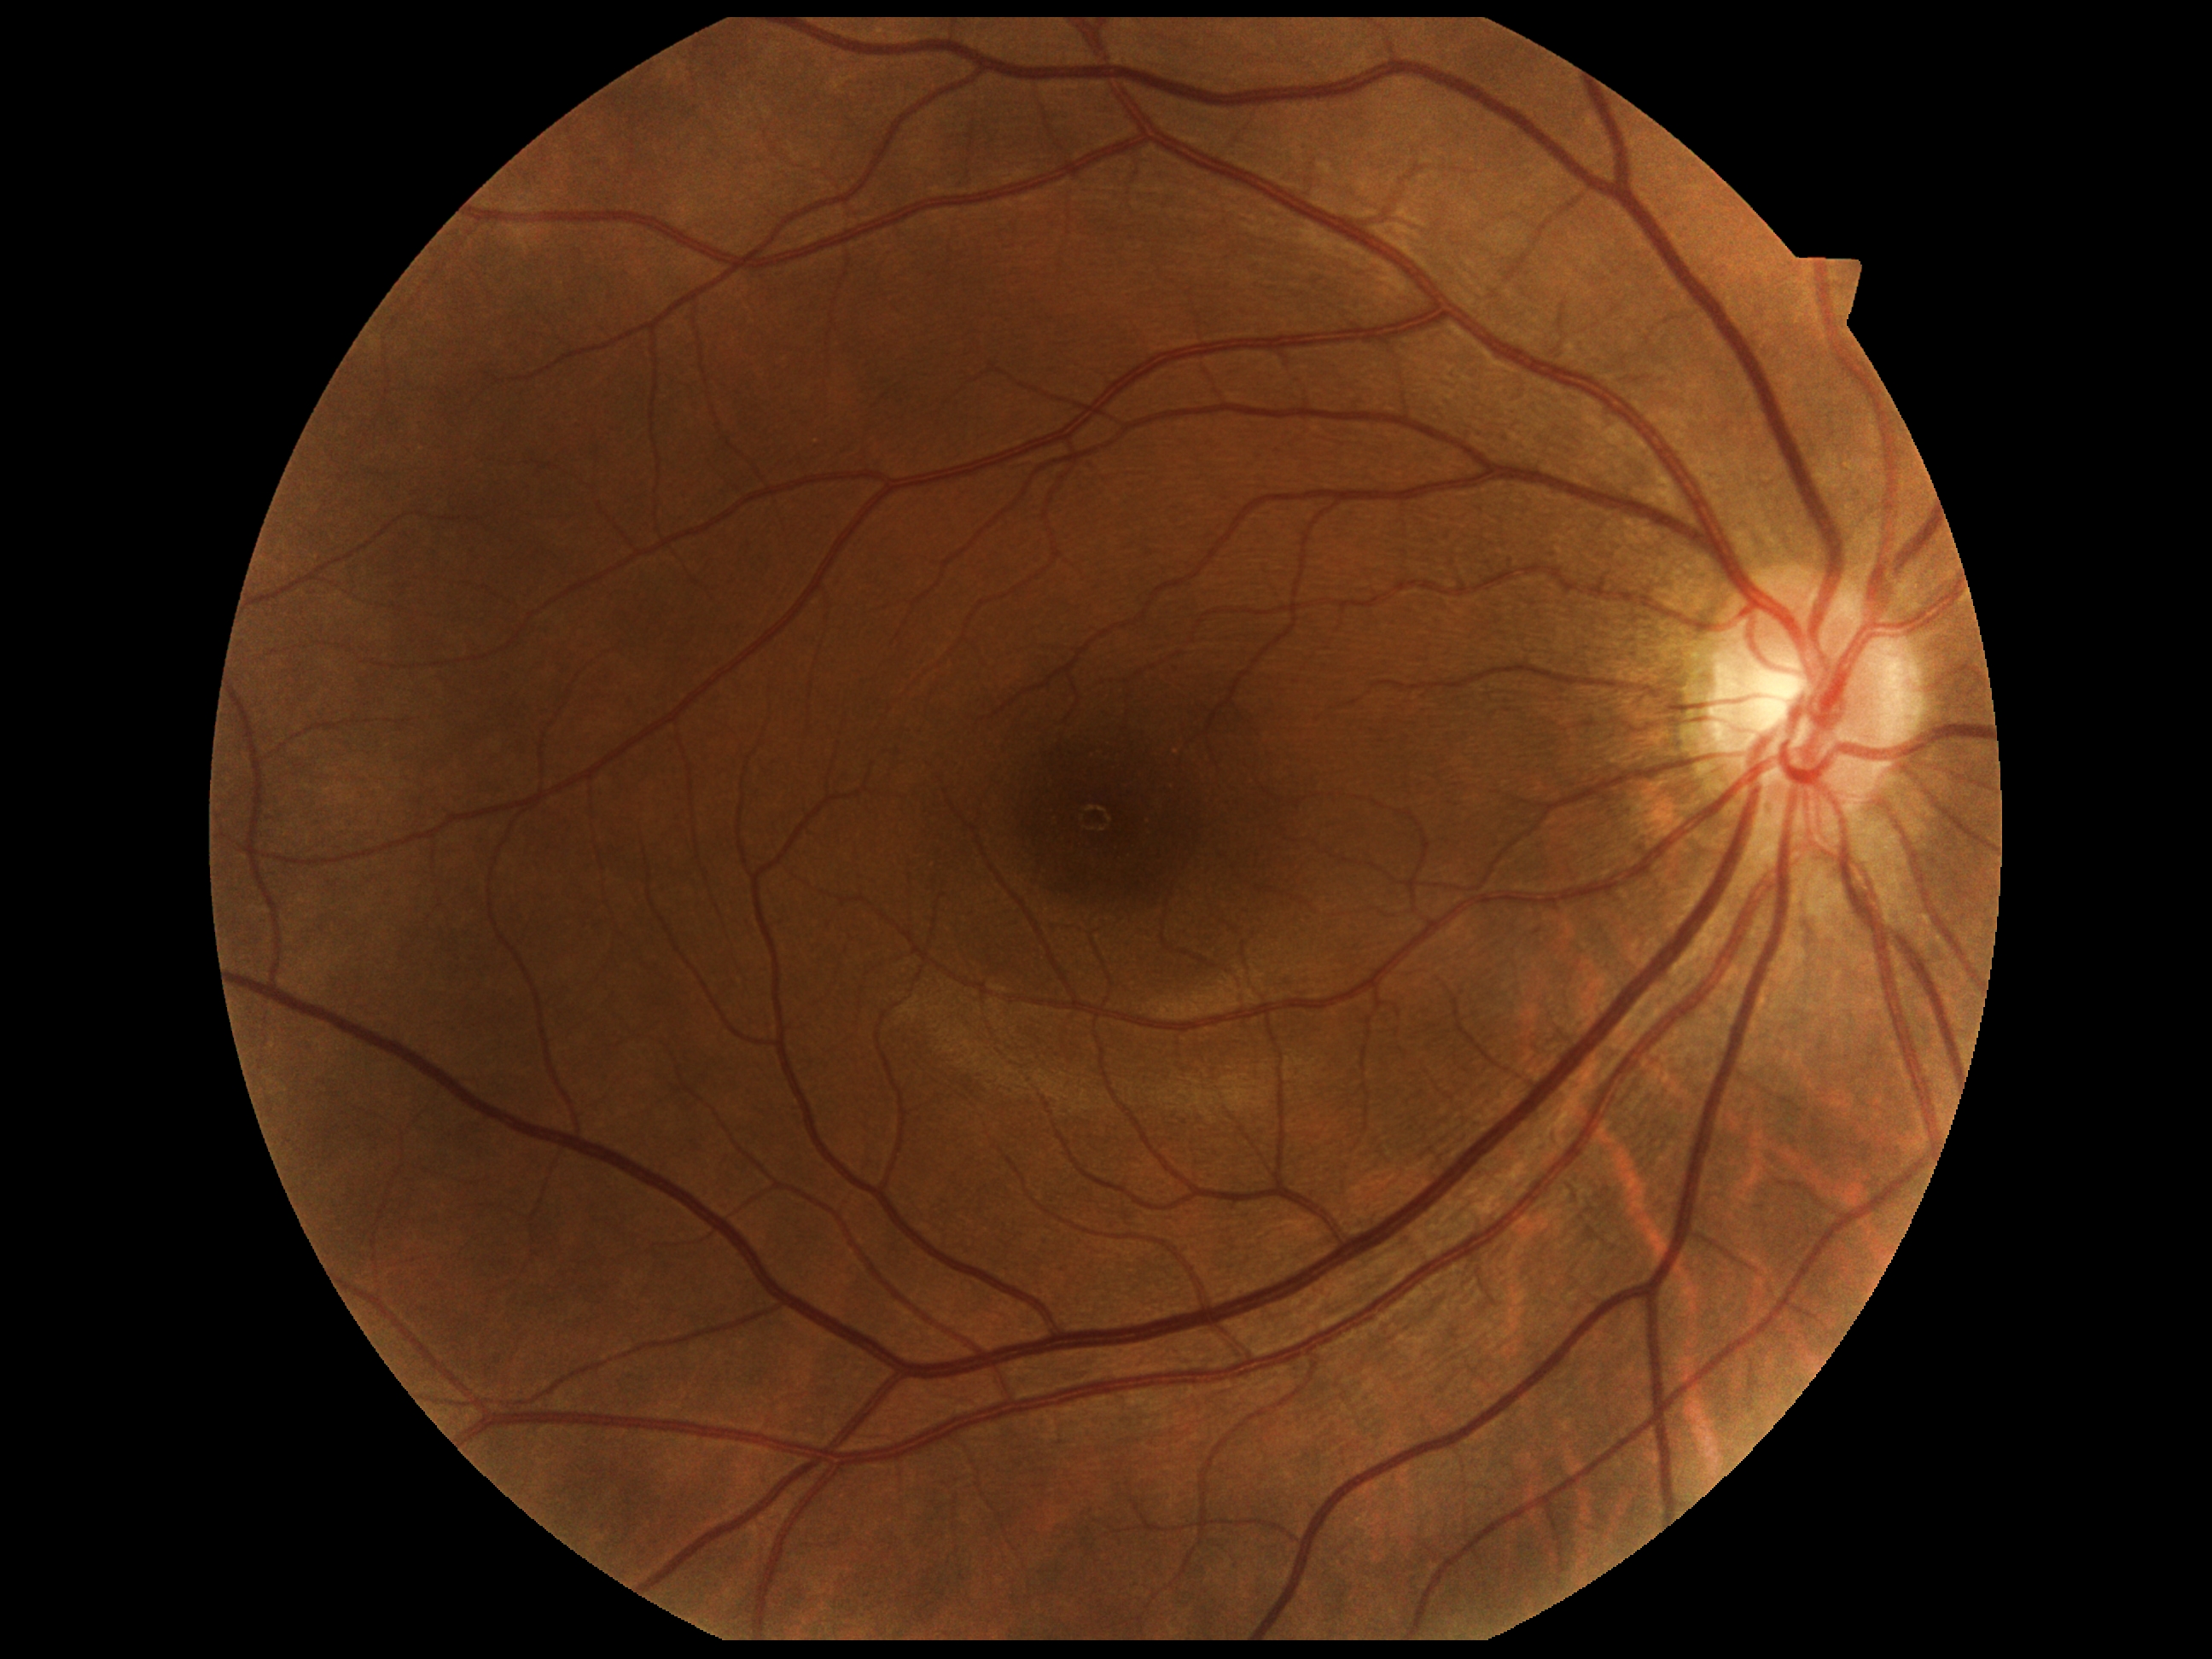

DR stage: no apparent diabetic retinopathy (grade 0).